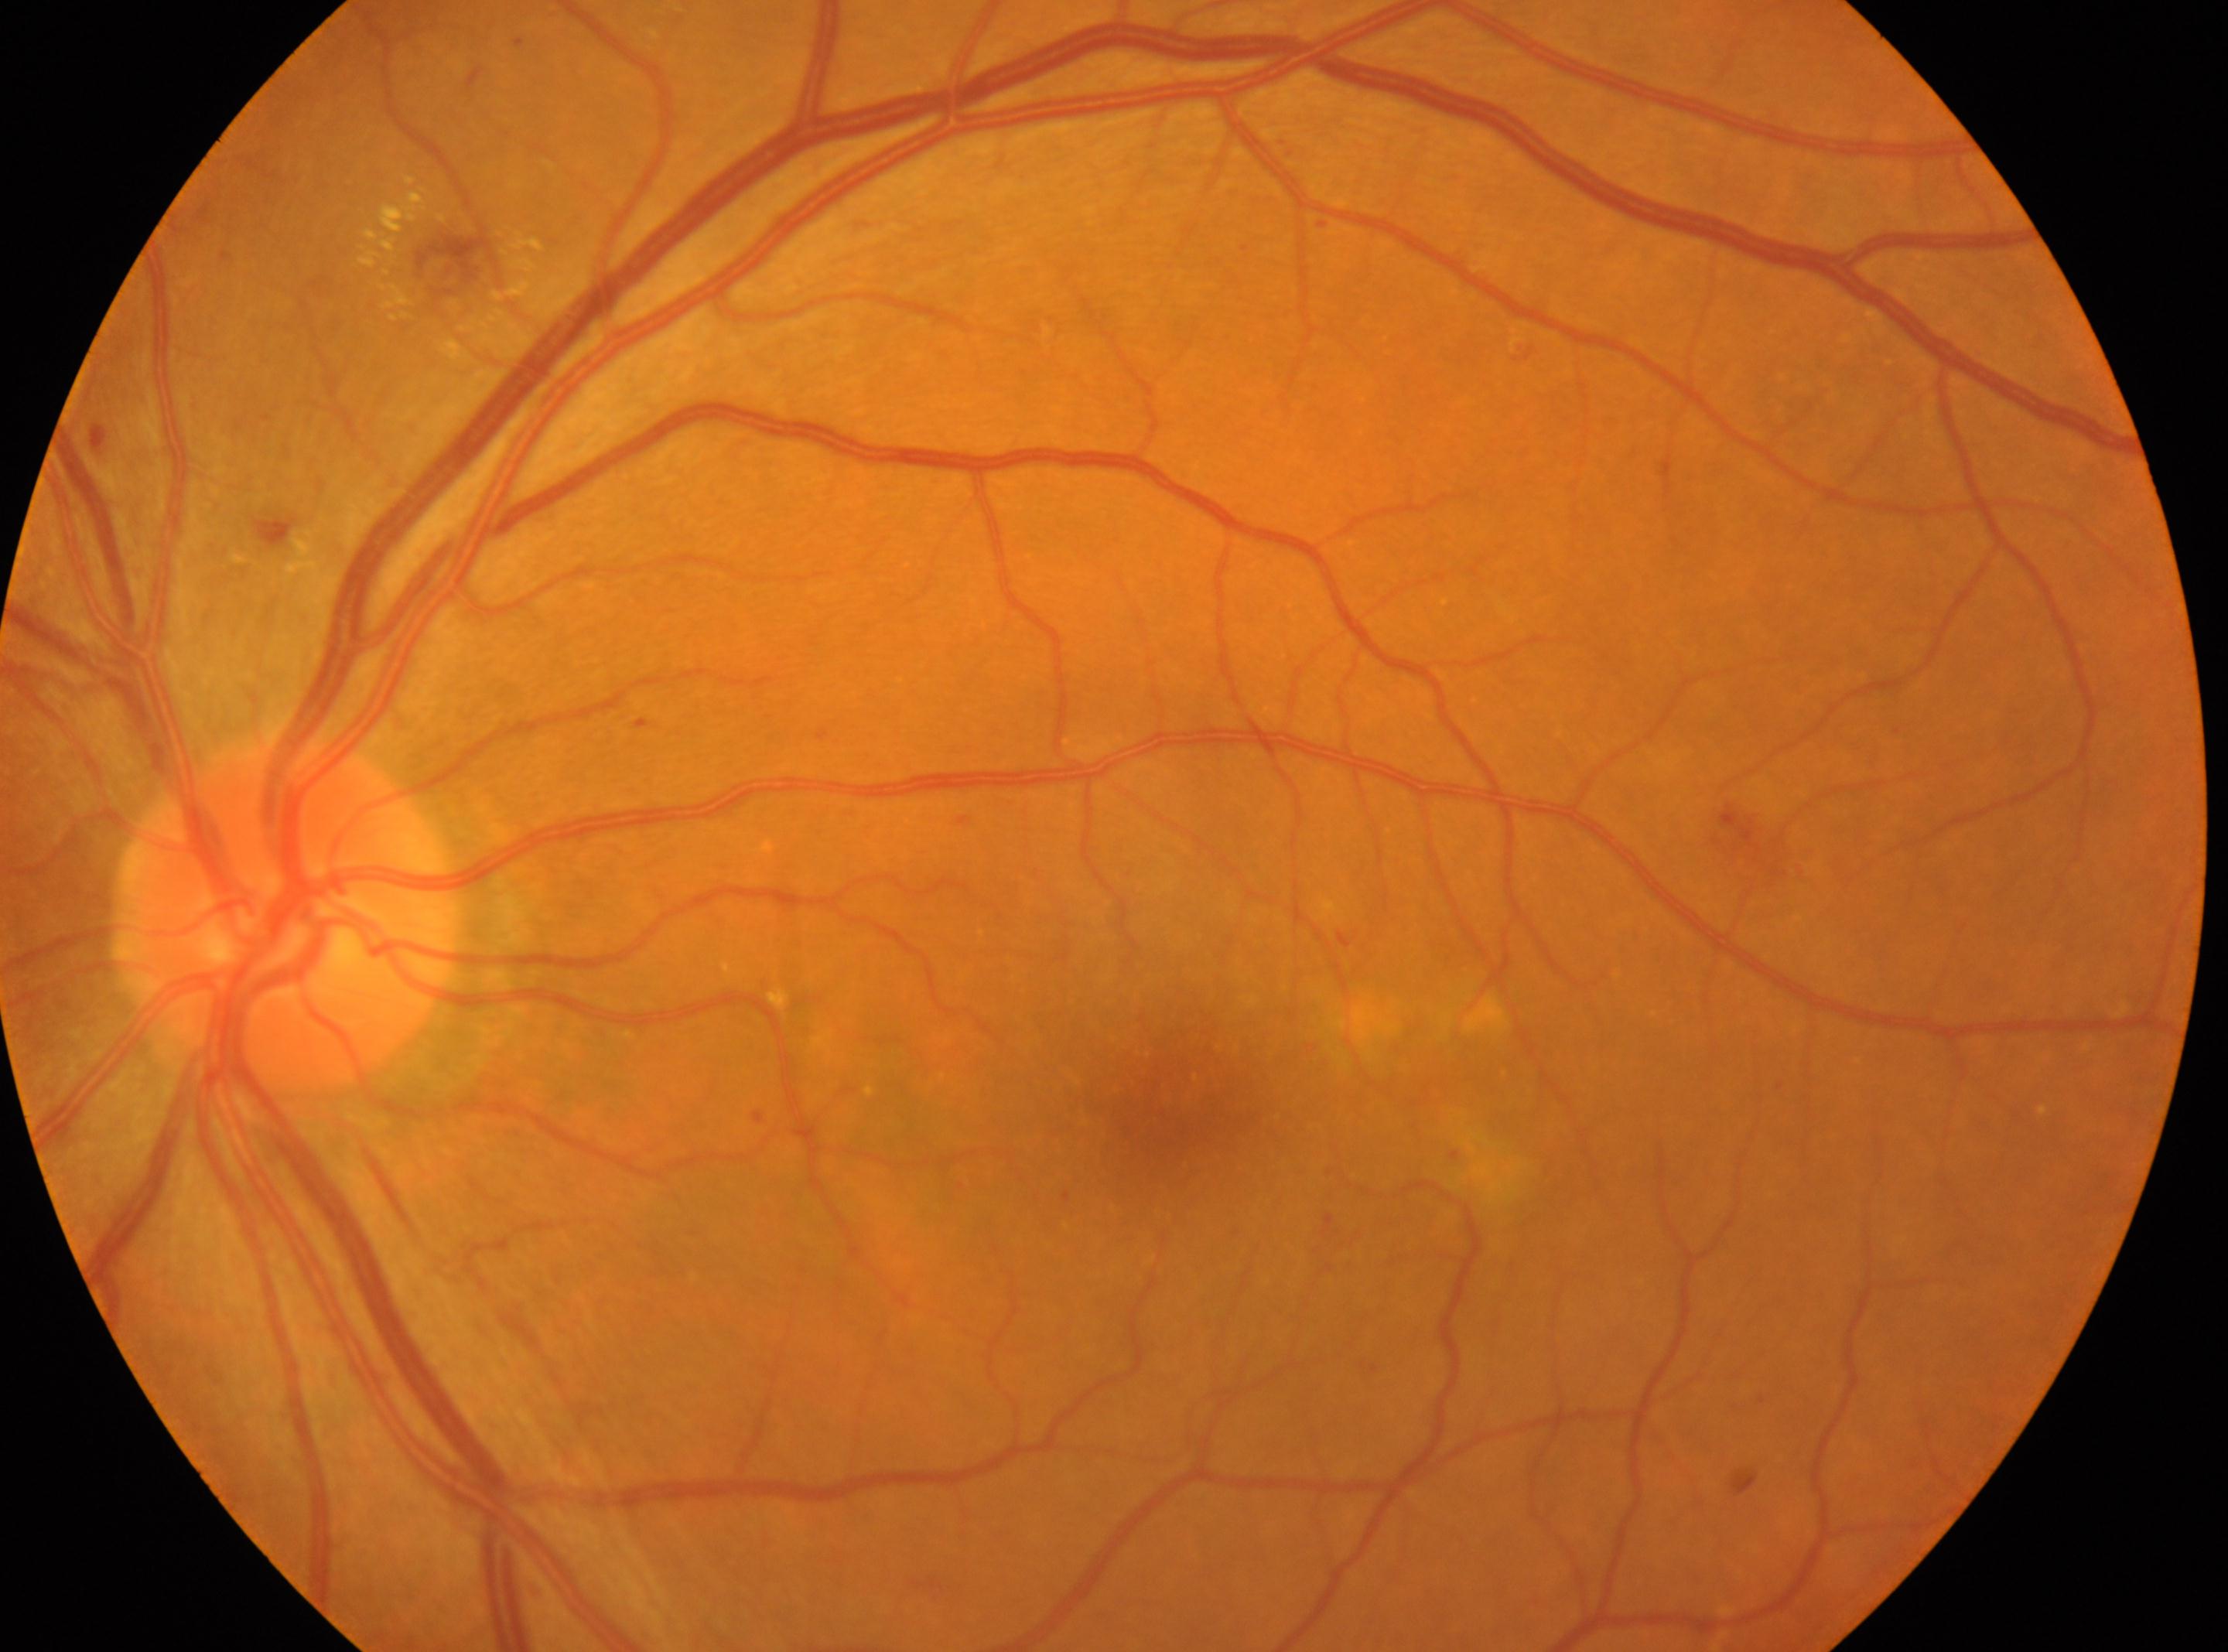 eye: OS
dr_grade: moderate NPDR (grade 2)
fovea: 1179, 1106
optic_disc: 288, 916